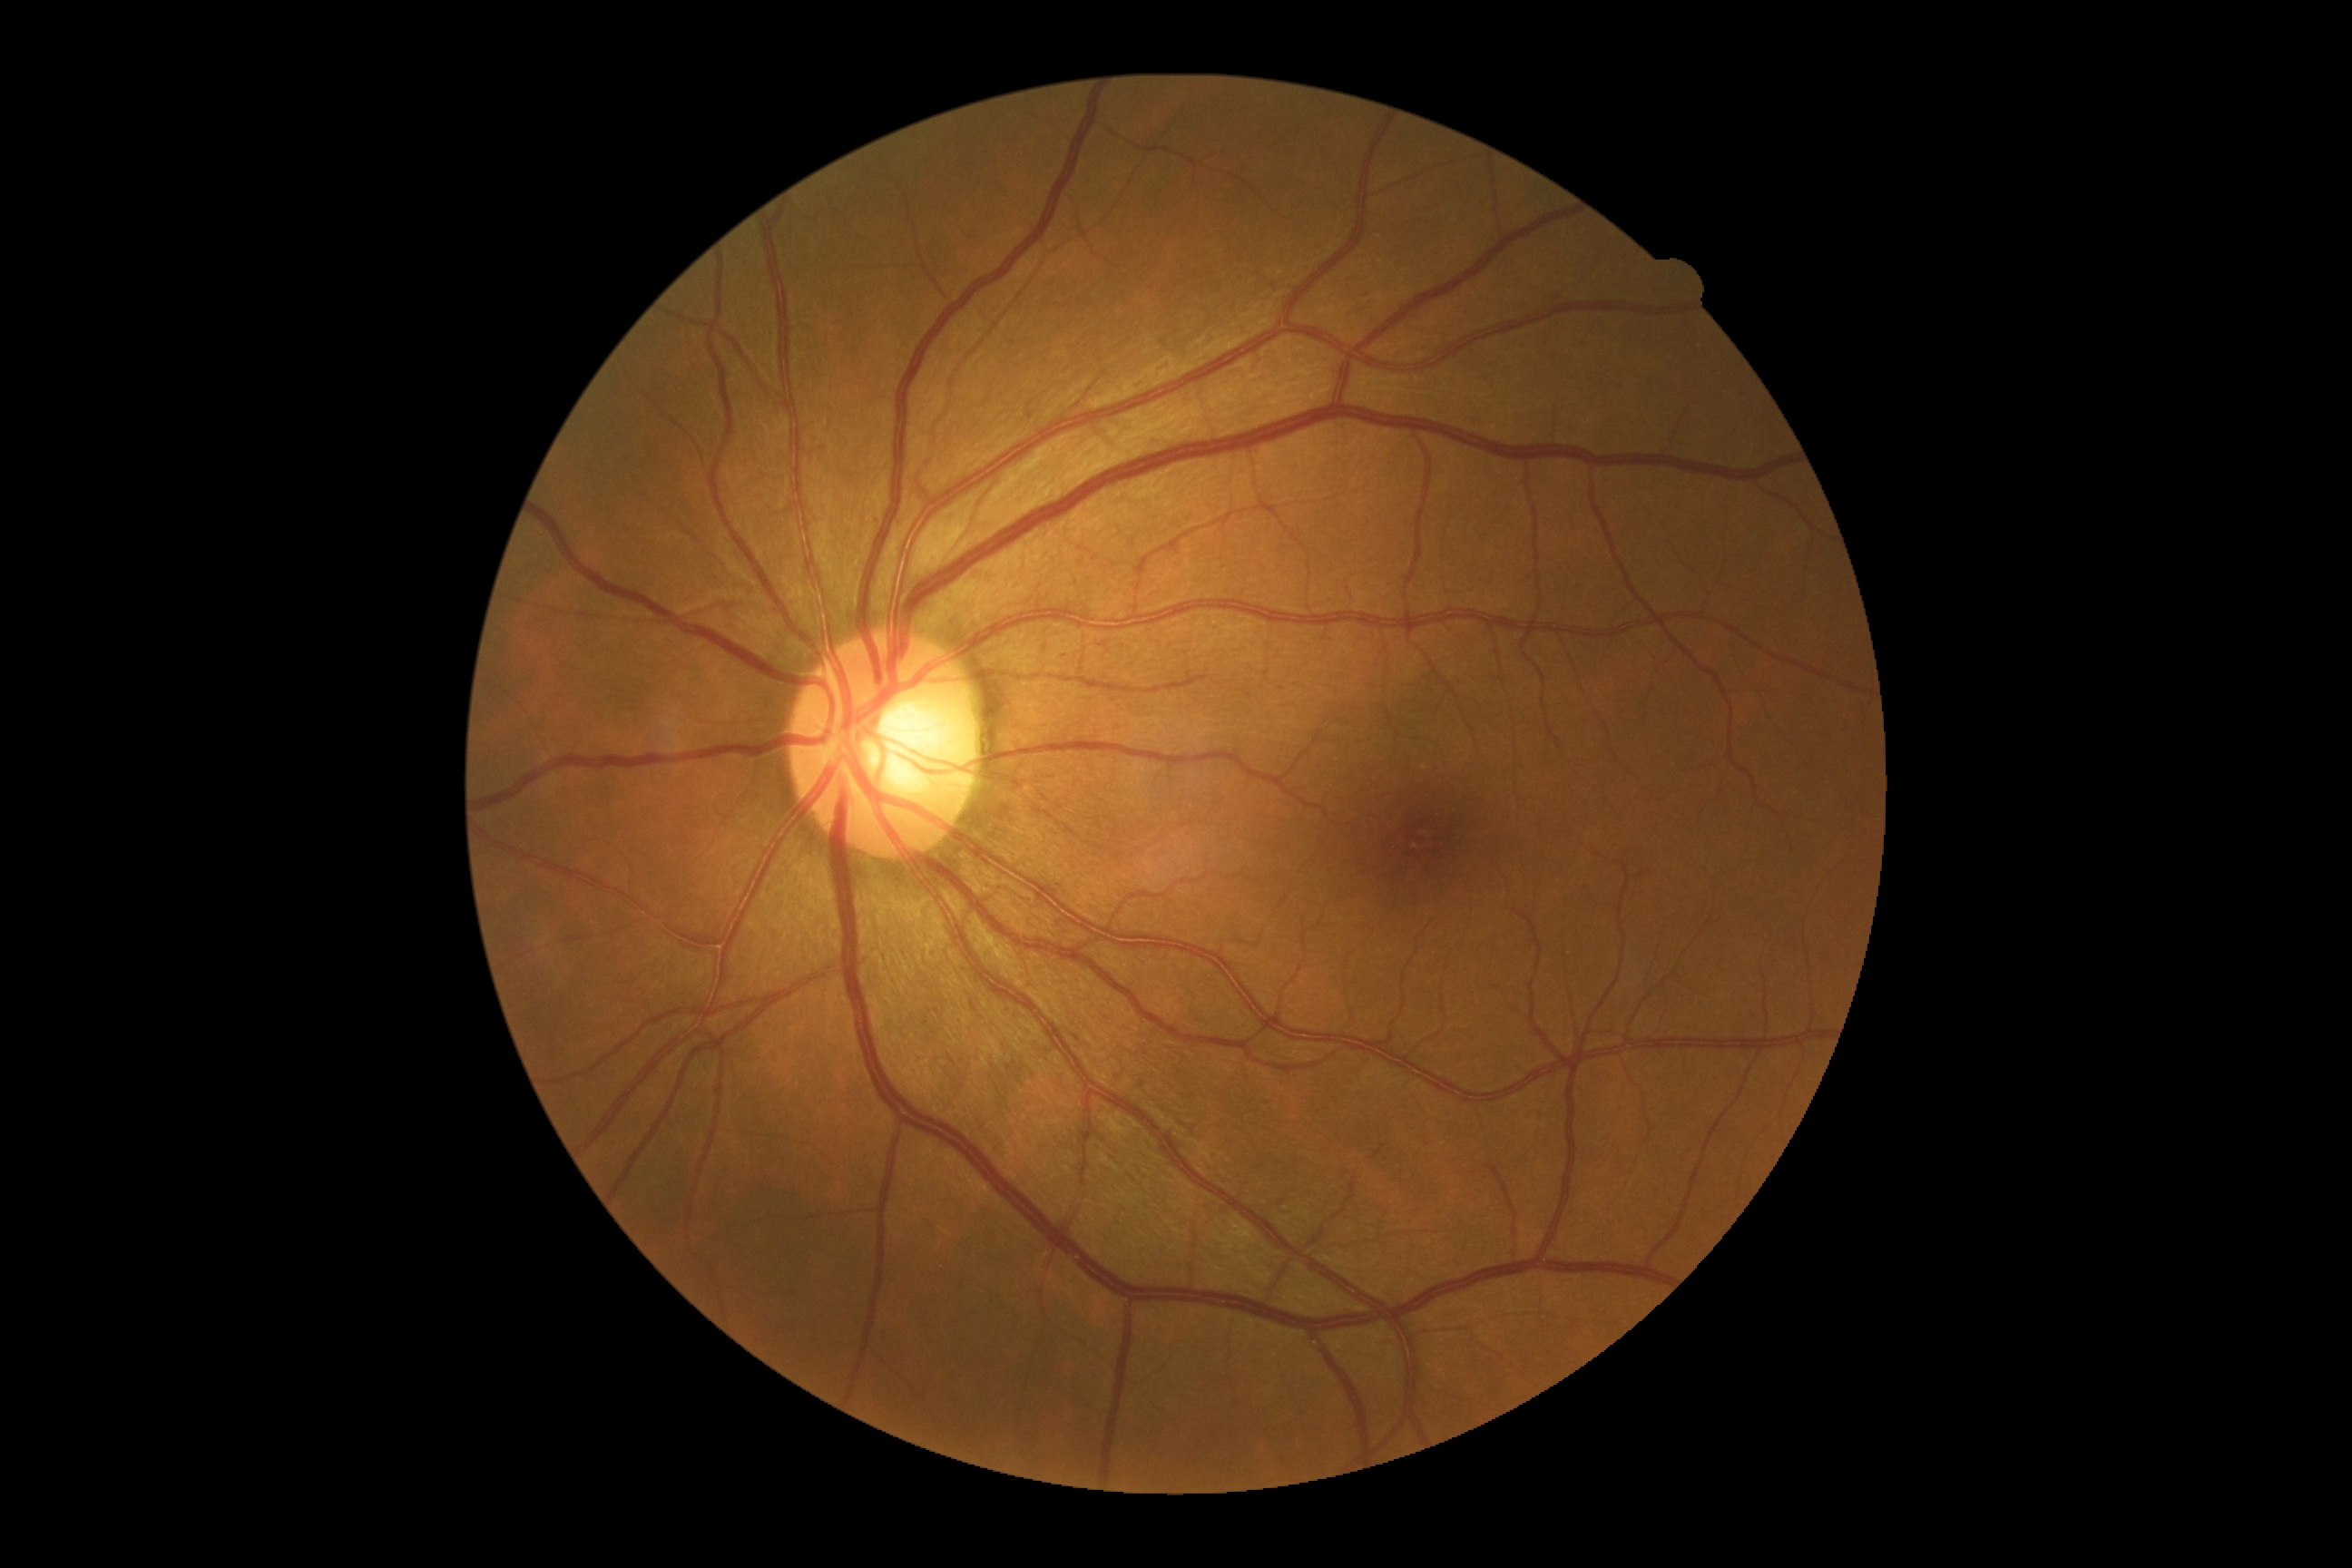 DR impression: no DR findings, diabetic retinopathy severity: no apparent retinopathy (grade 0).